Captured with pupil dilation; ONH-centered crop from a color fundus image; captured on a Topcon TRC retinal camera:
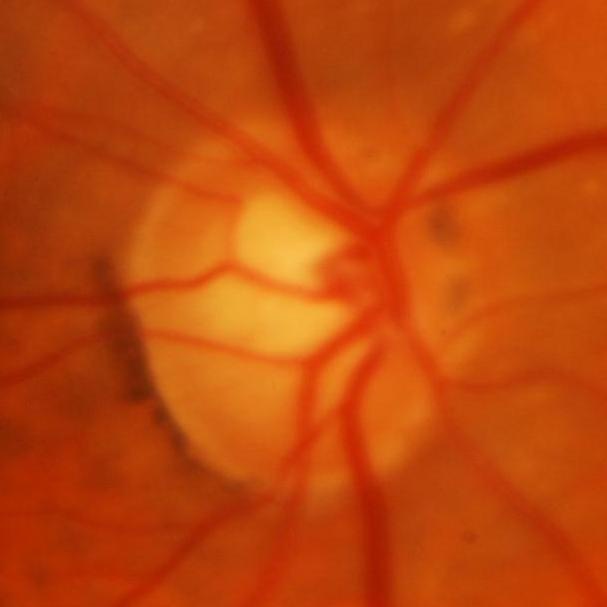 Findings consistent with glaucoma.